100° field of view (Phoenix ICON) · pediatric wide-field fundus photograph · 1240x1240:
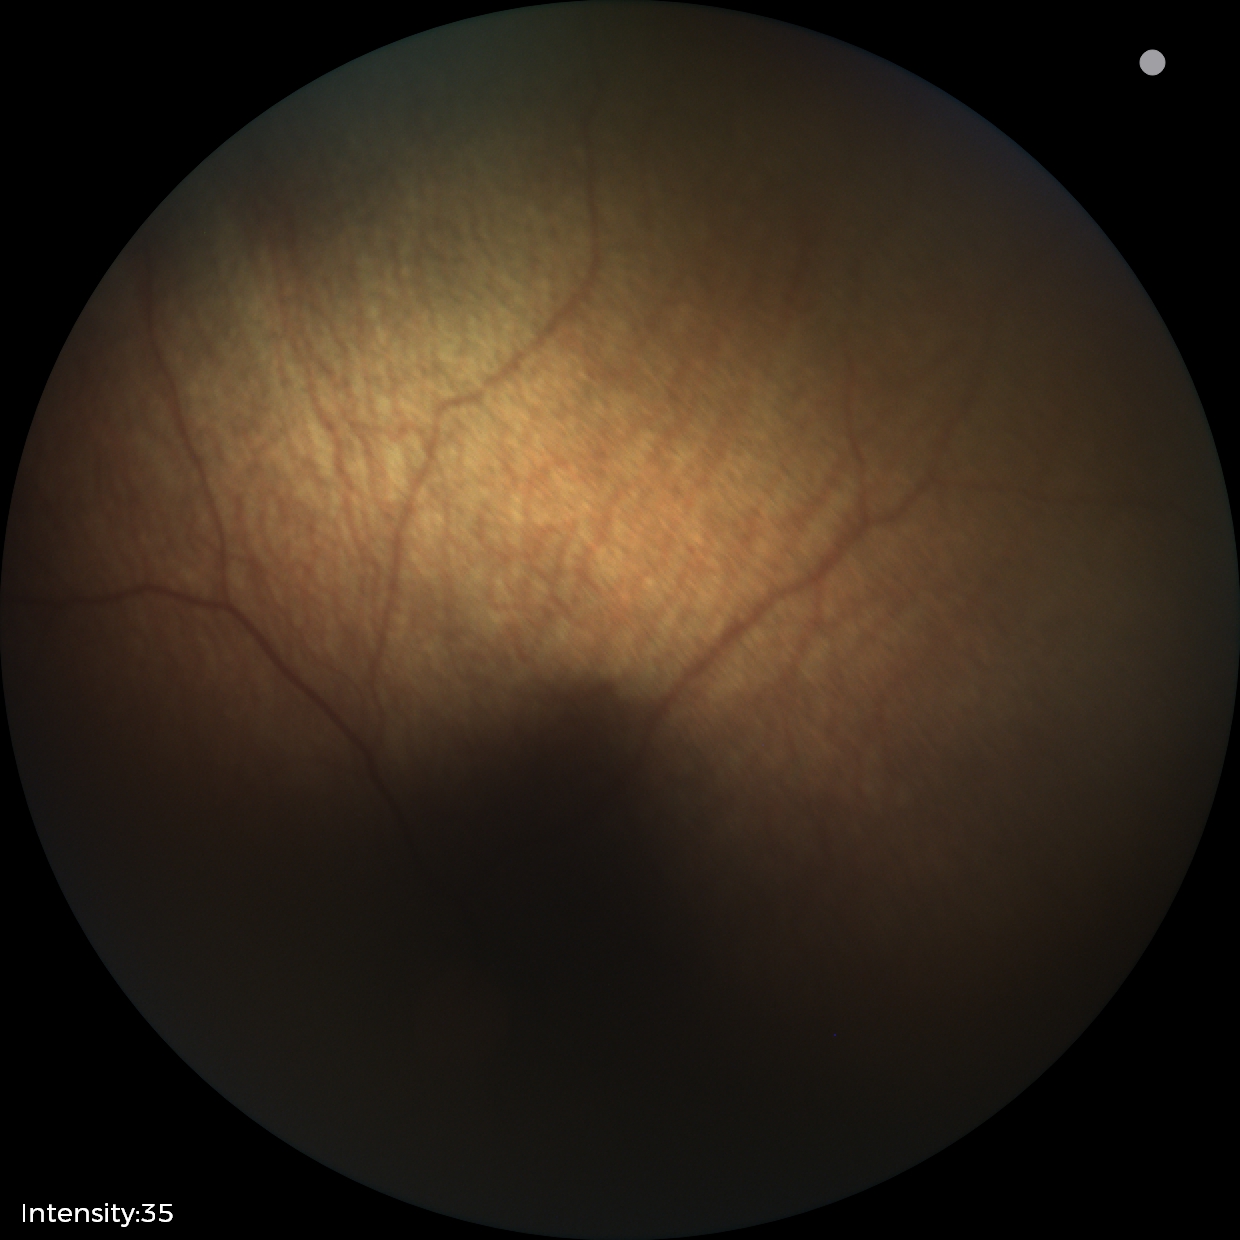 No retinal pathology identified on screening.